Wide-field contact fundus photograph of an infant:
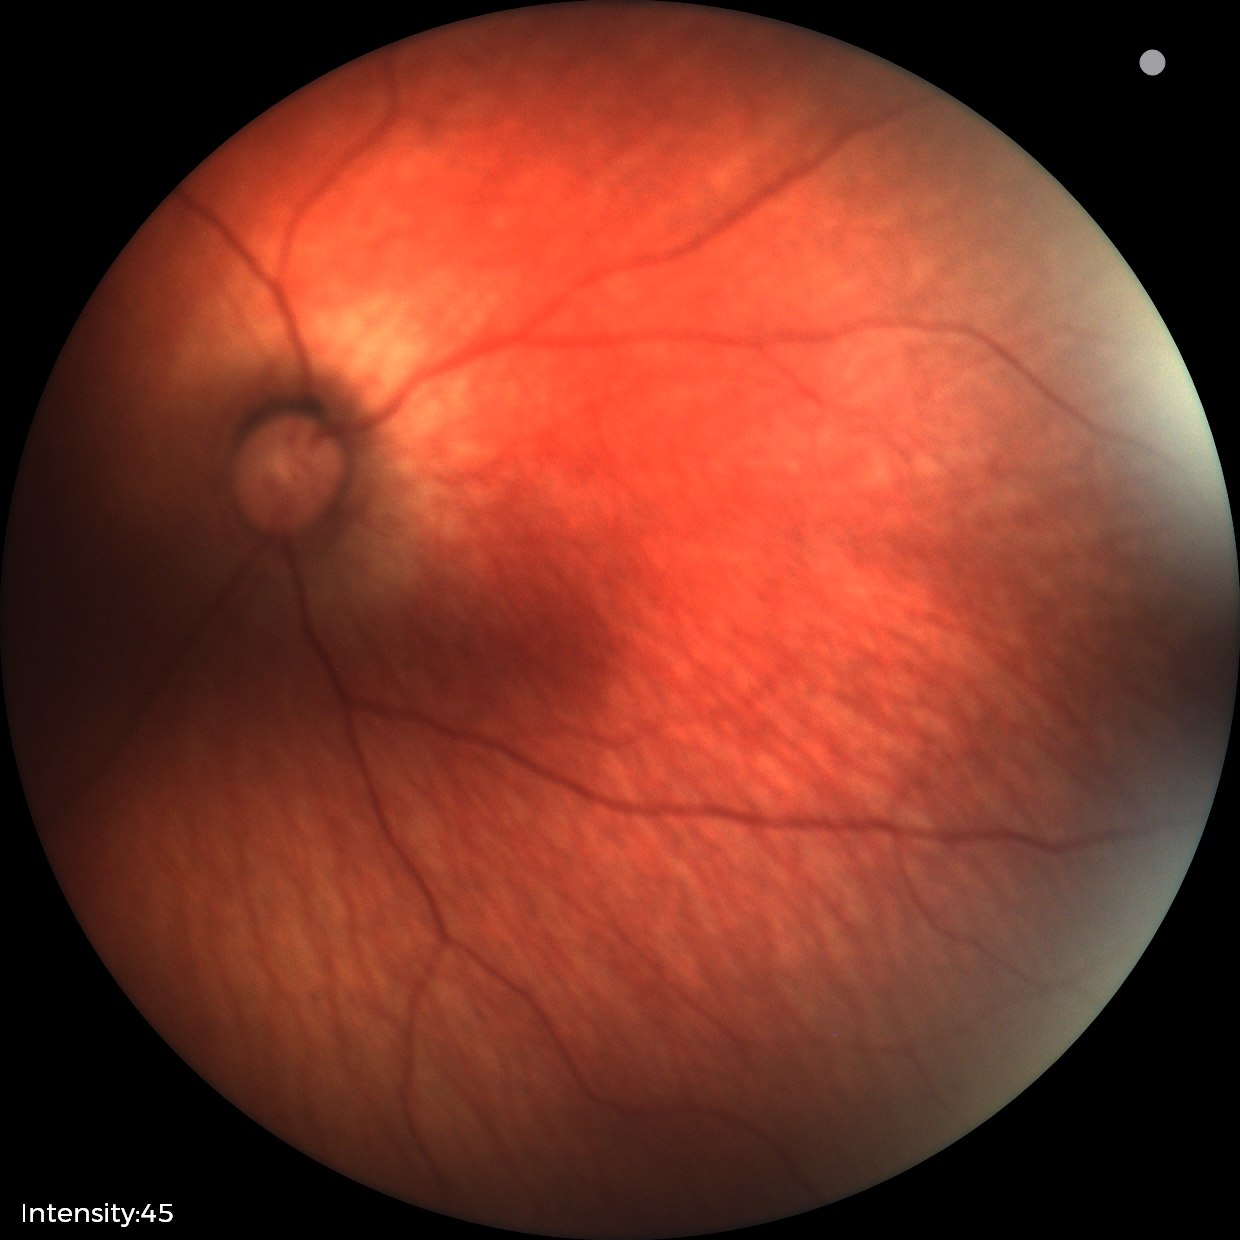
Screening: physiological retinal finding.